2212 x 1659 pixels; FOV: 45 degrees
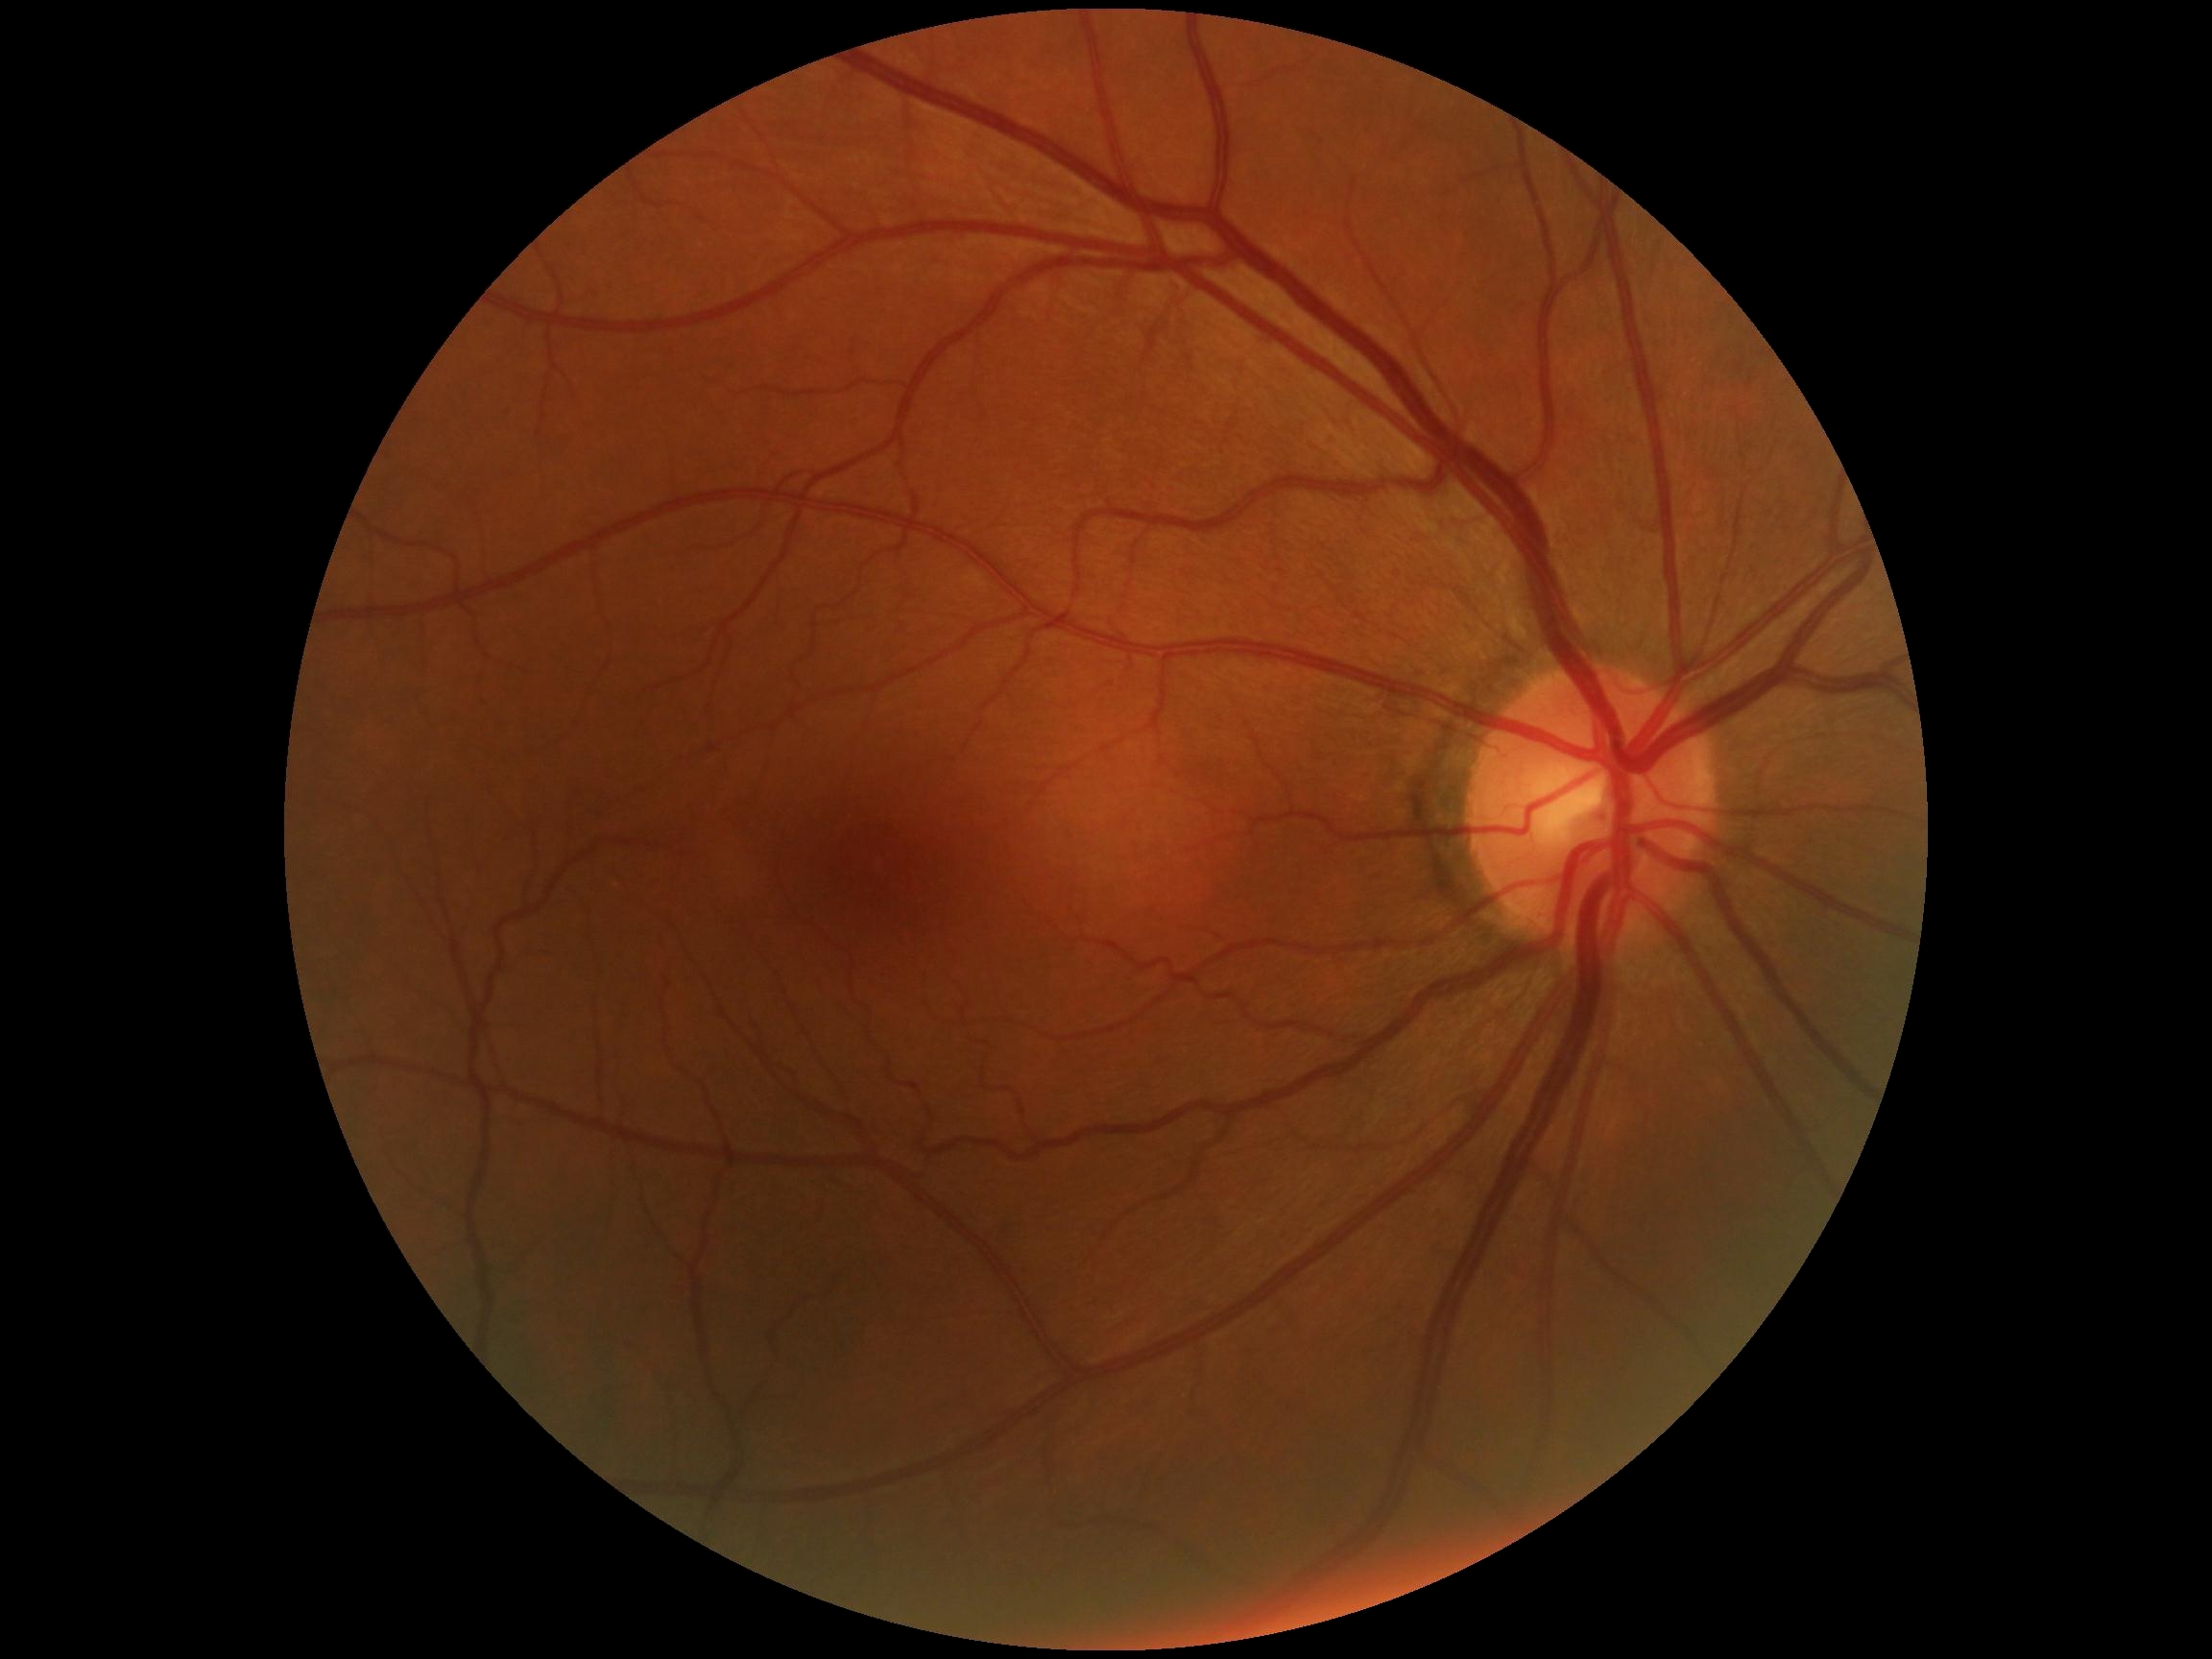

diabetic retinopathy (DR) = 0; DR impression = negative for DR.